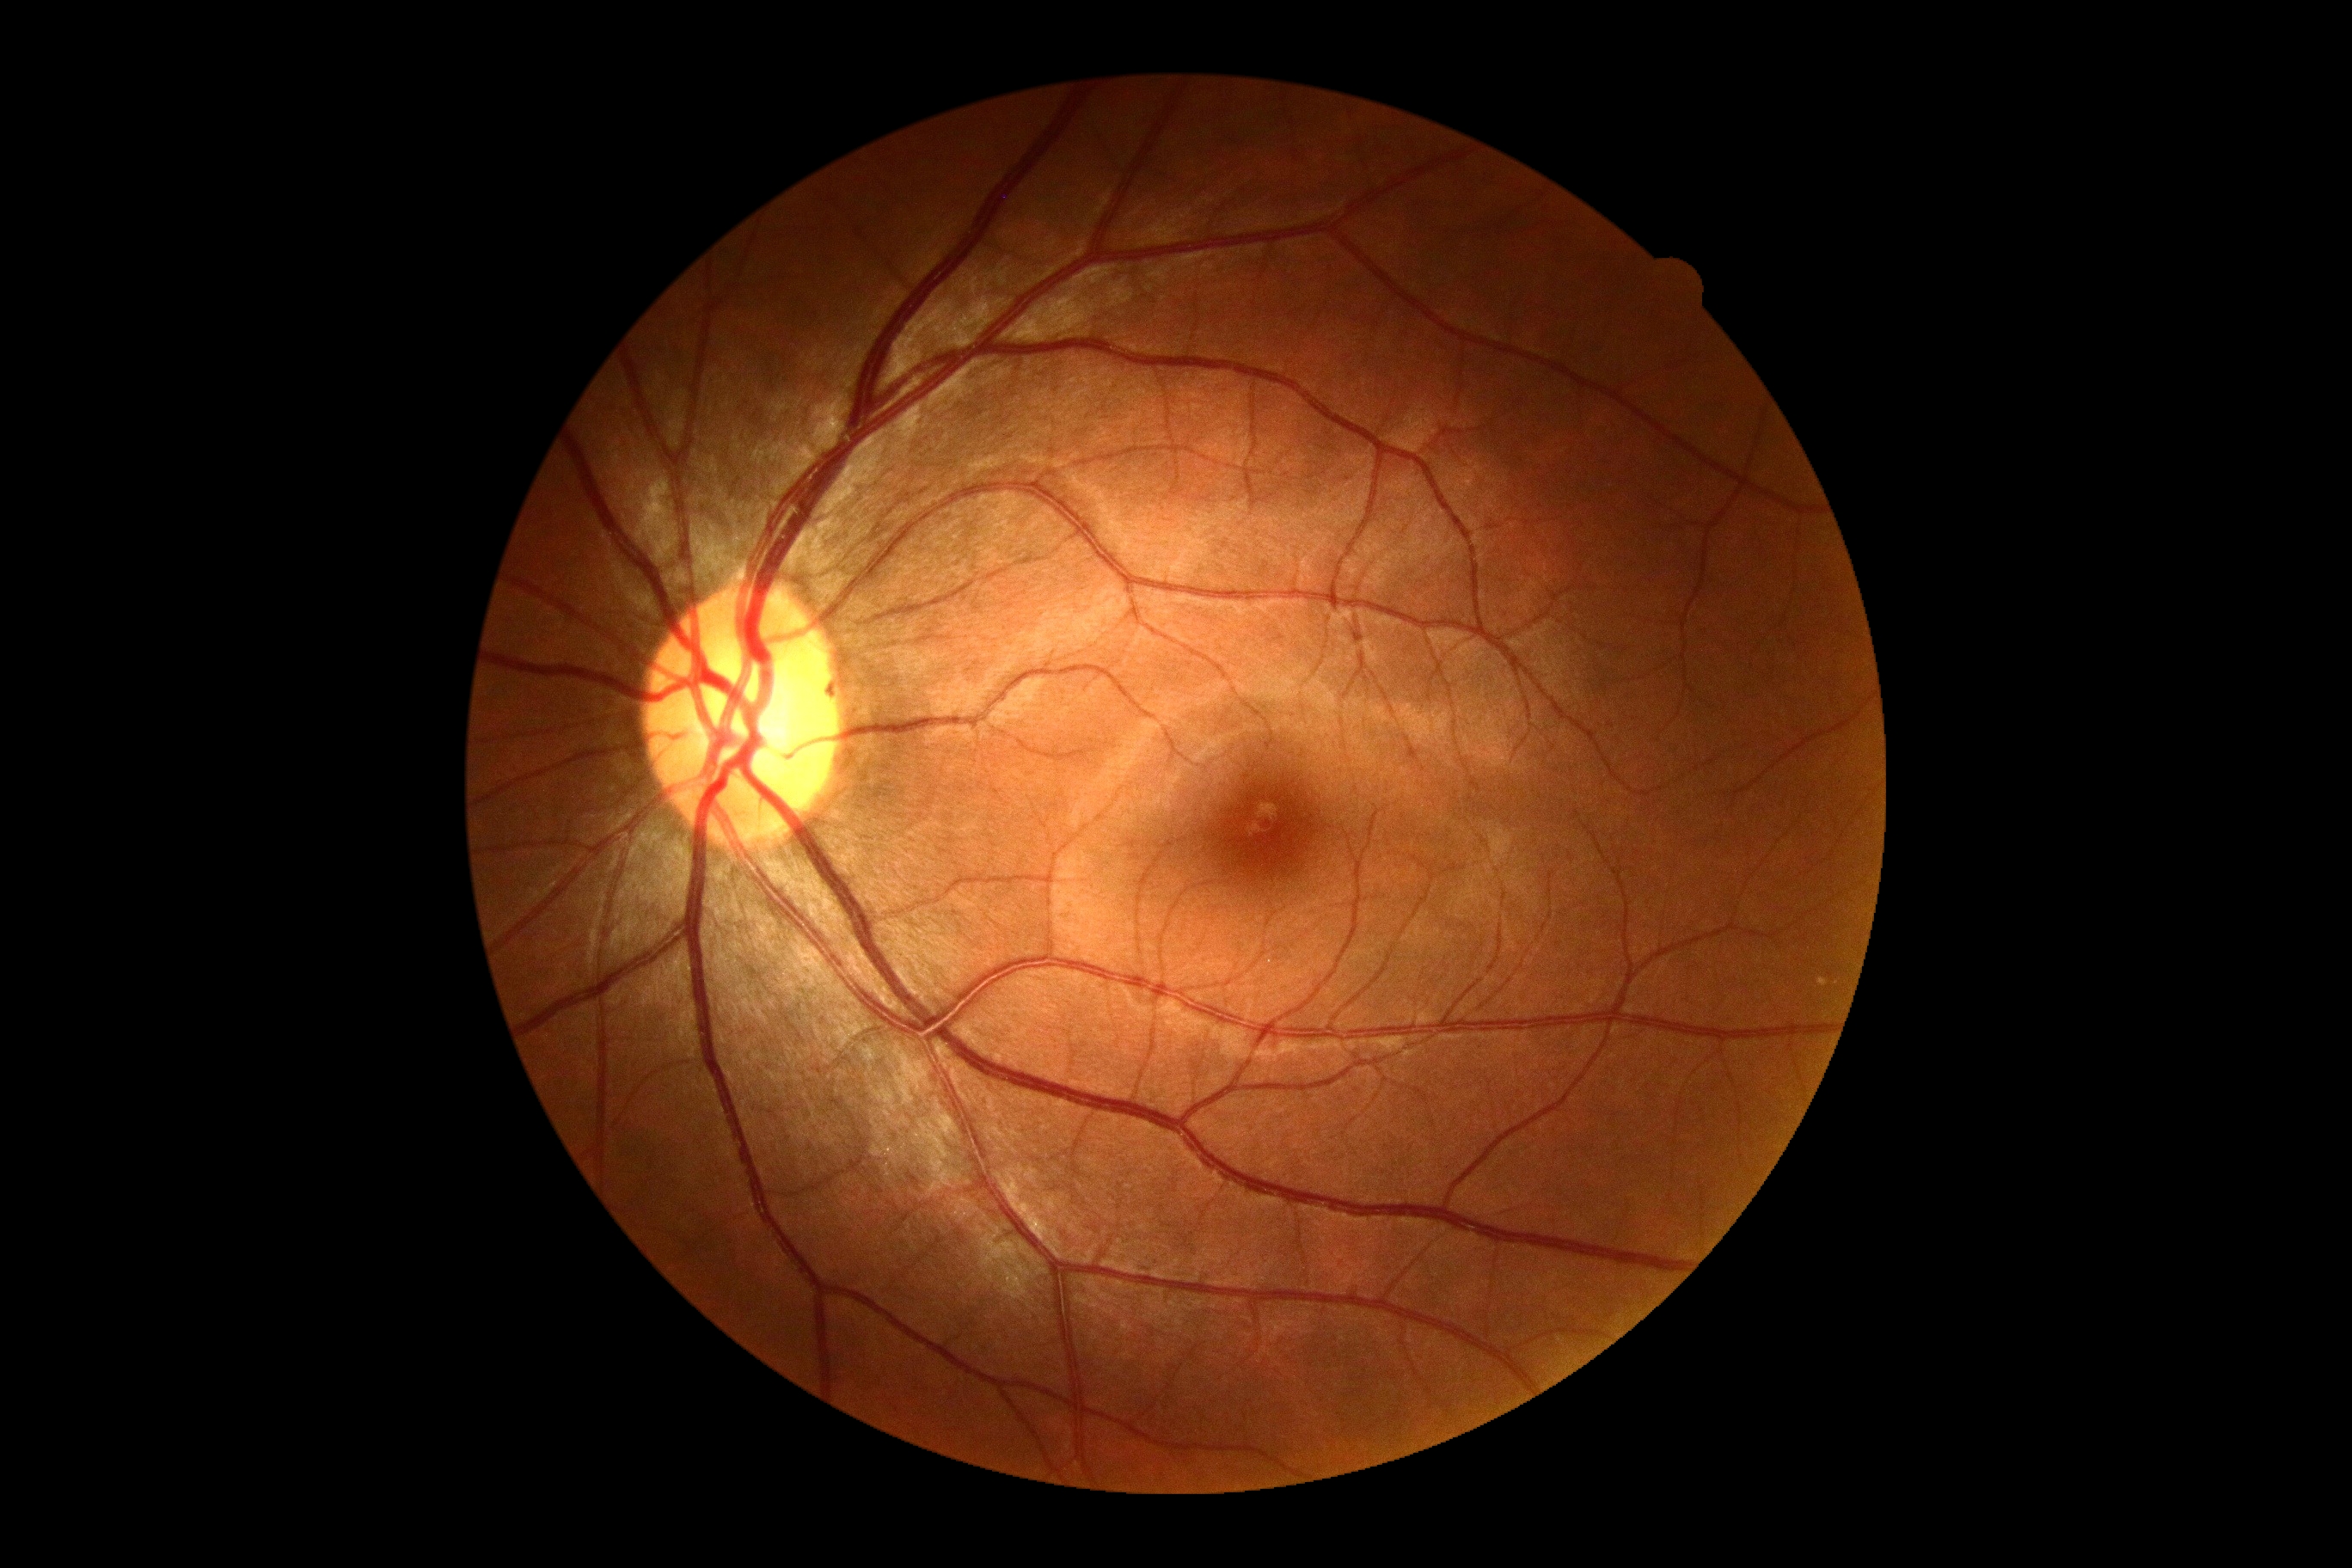

DR impression@negative for DR; DR severity@no apparent diabetic retinopathy (grade 0).